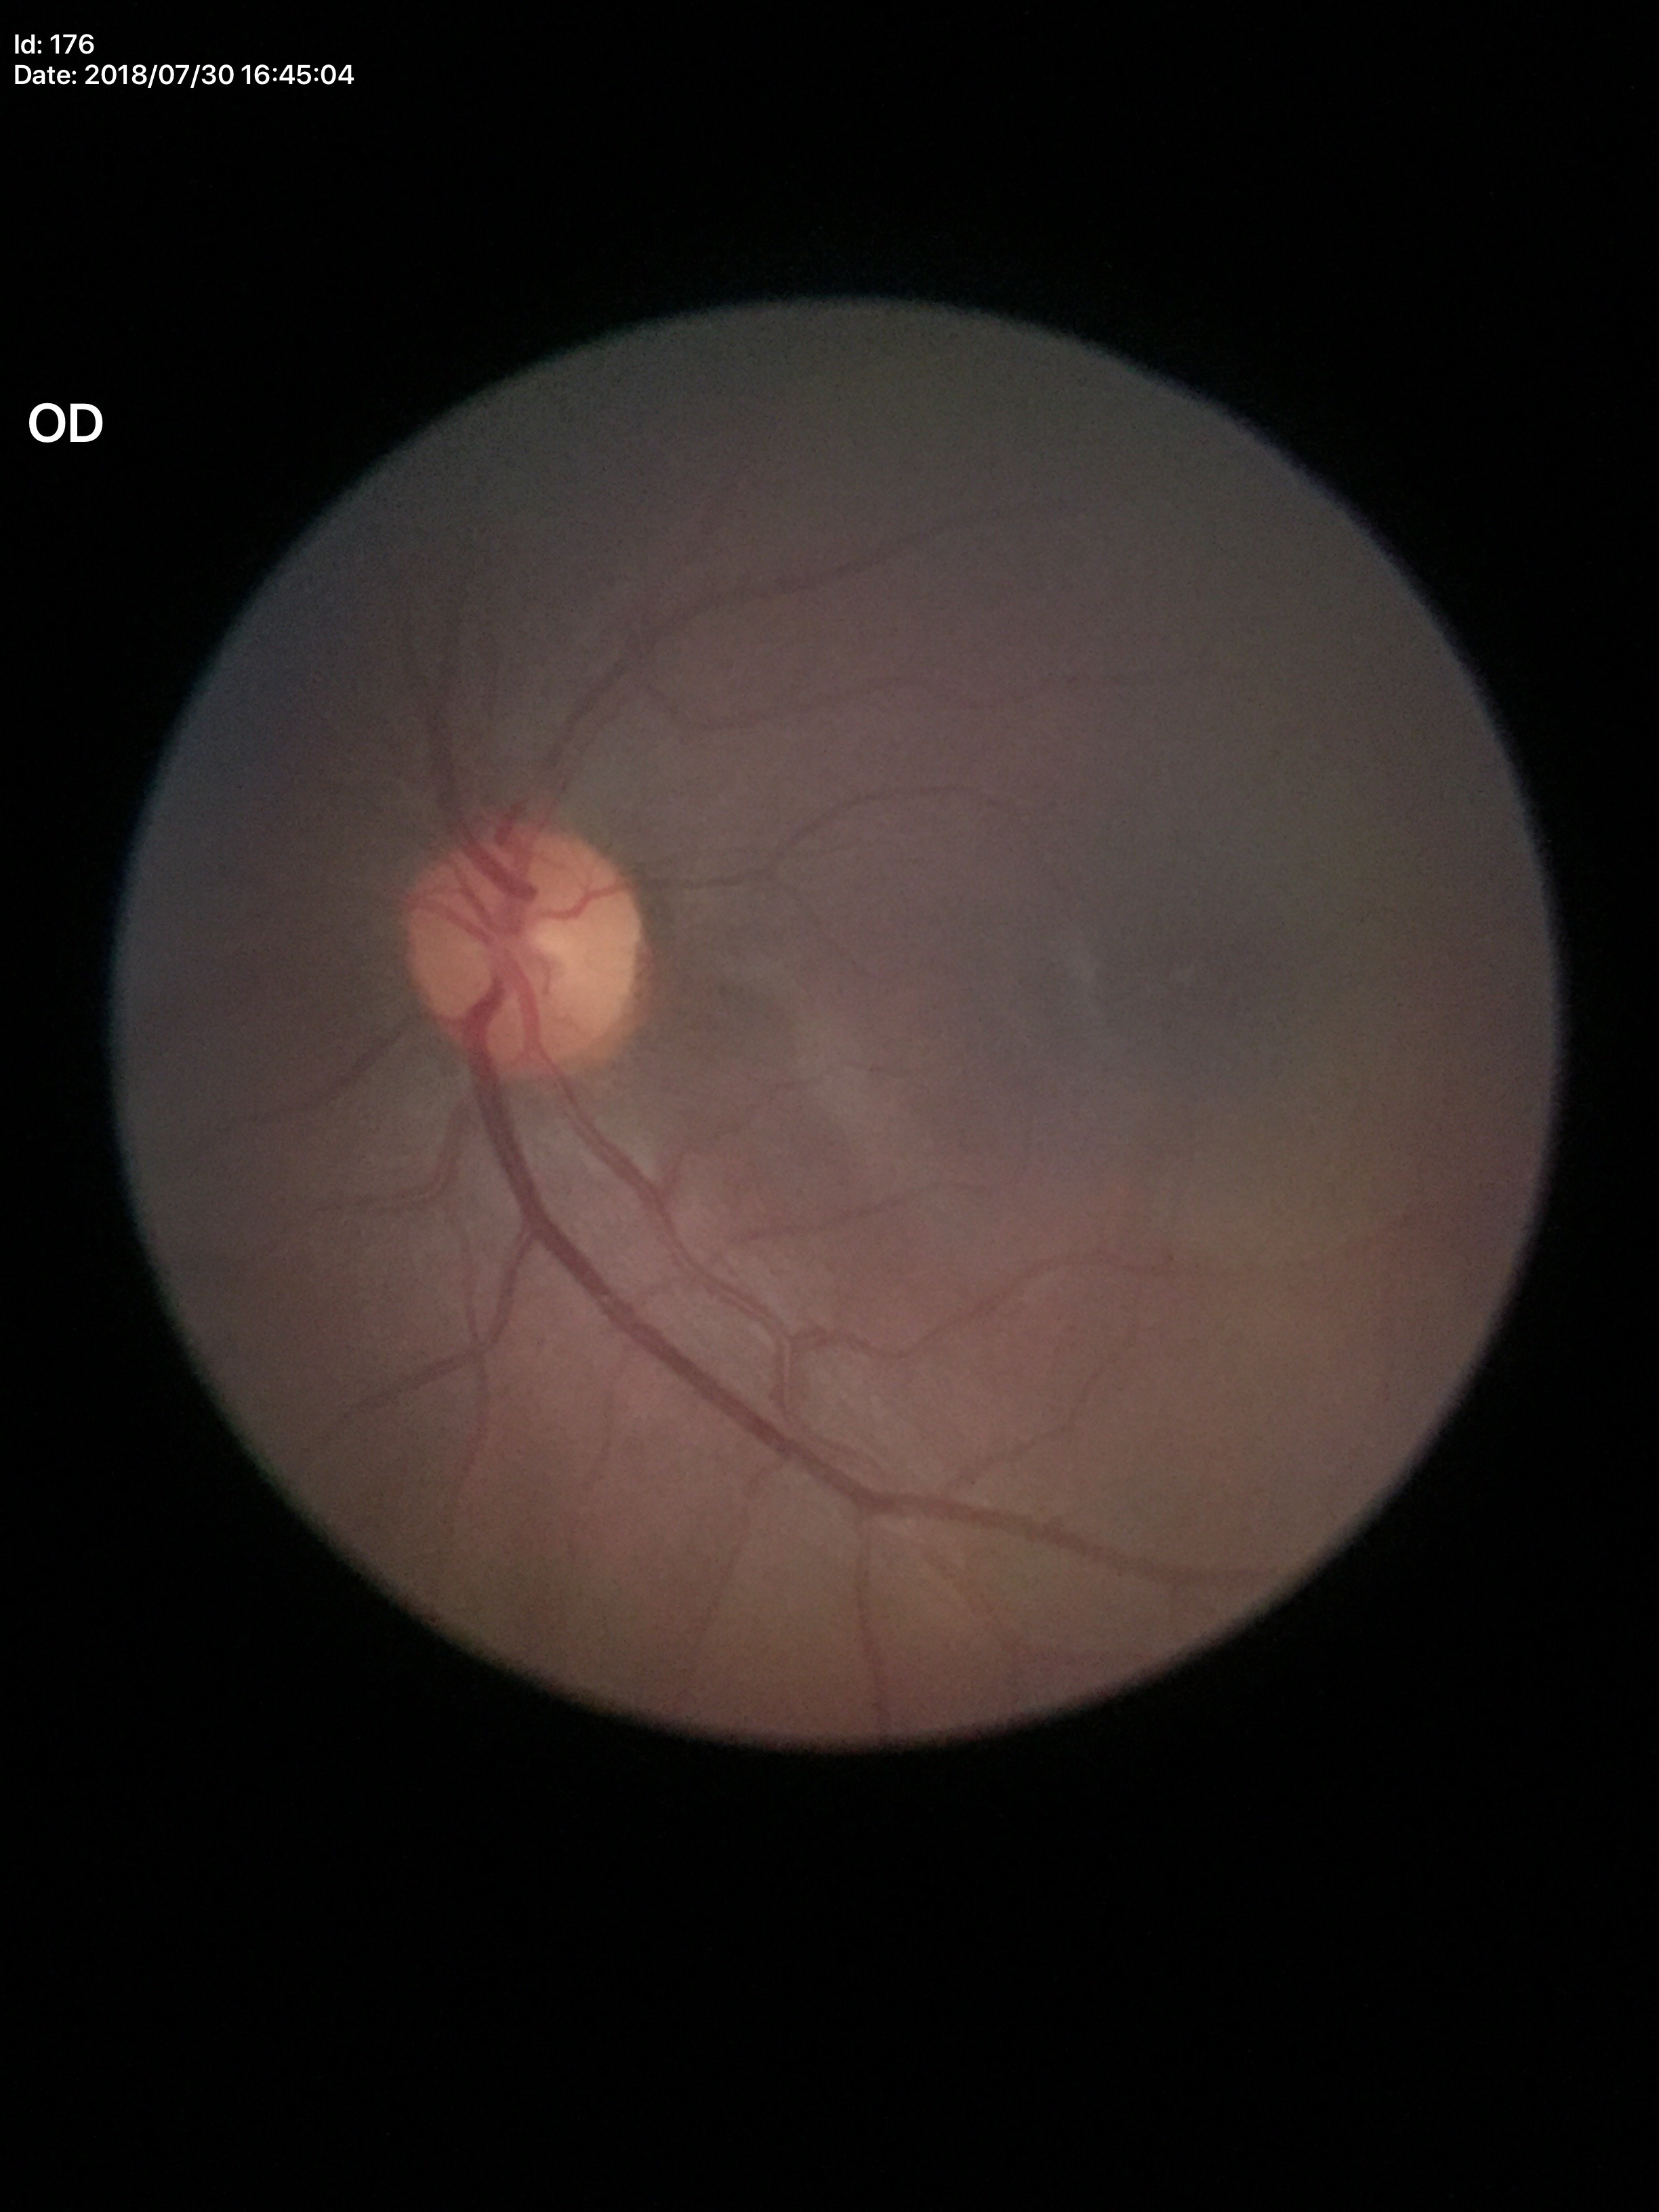 Negative for glaucoma suspicion.
Area CDR (ACDR) of 0.18.
Vertical C/D ratio (VCDR): 0.44.